Modified Davis classification. 45° FOV: 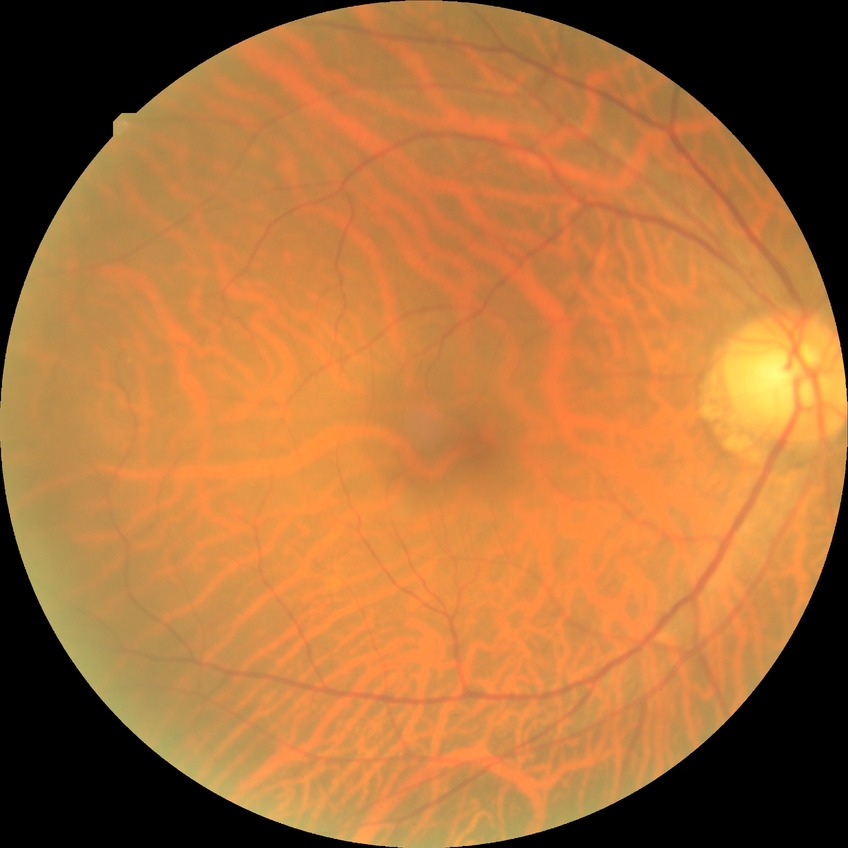

Davis grading: no diabetic retinopathy.